Wide-field contact fundus photograph of an infant · 640 x 480 pixels — 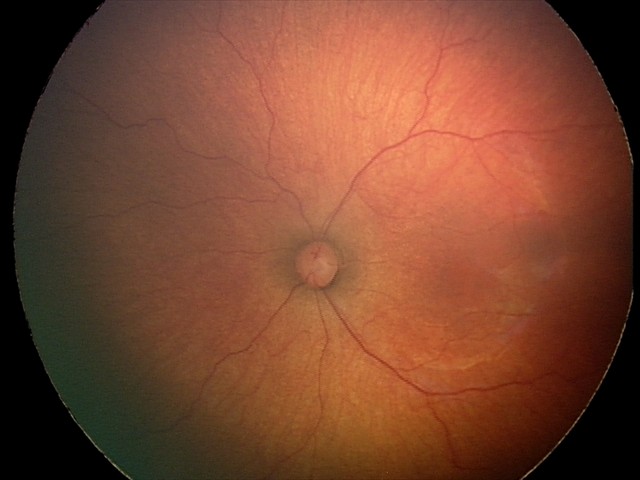
Q: What was the screening finding?
A: status post retinopathy of prematurity (ROP)